Color fundus image.
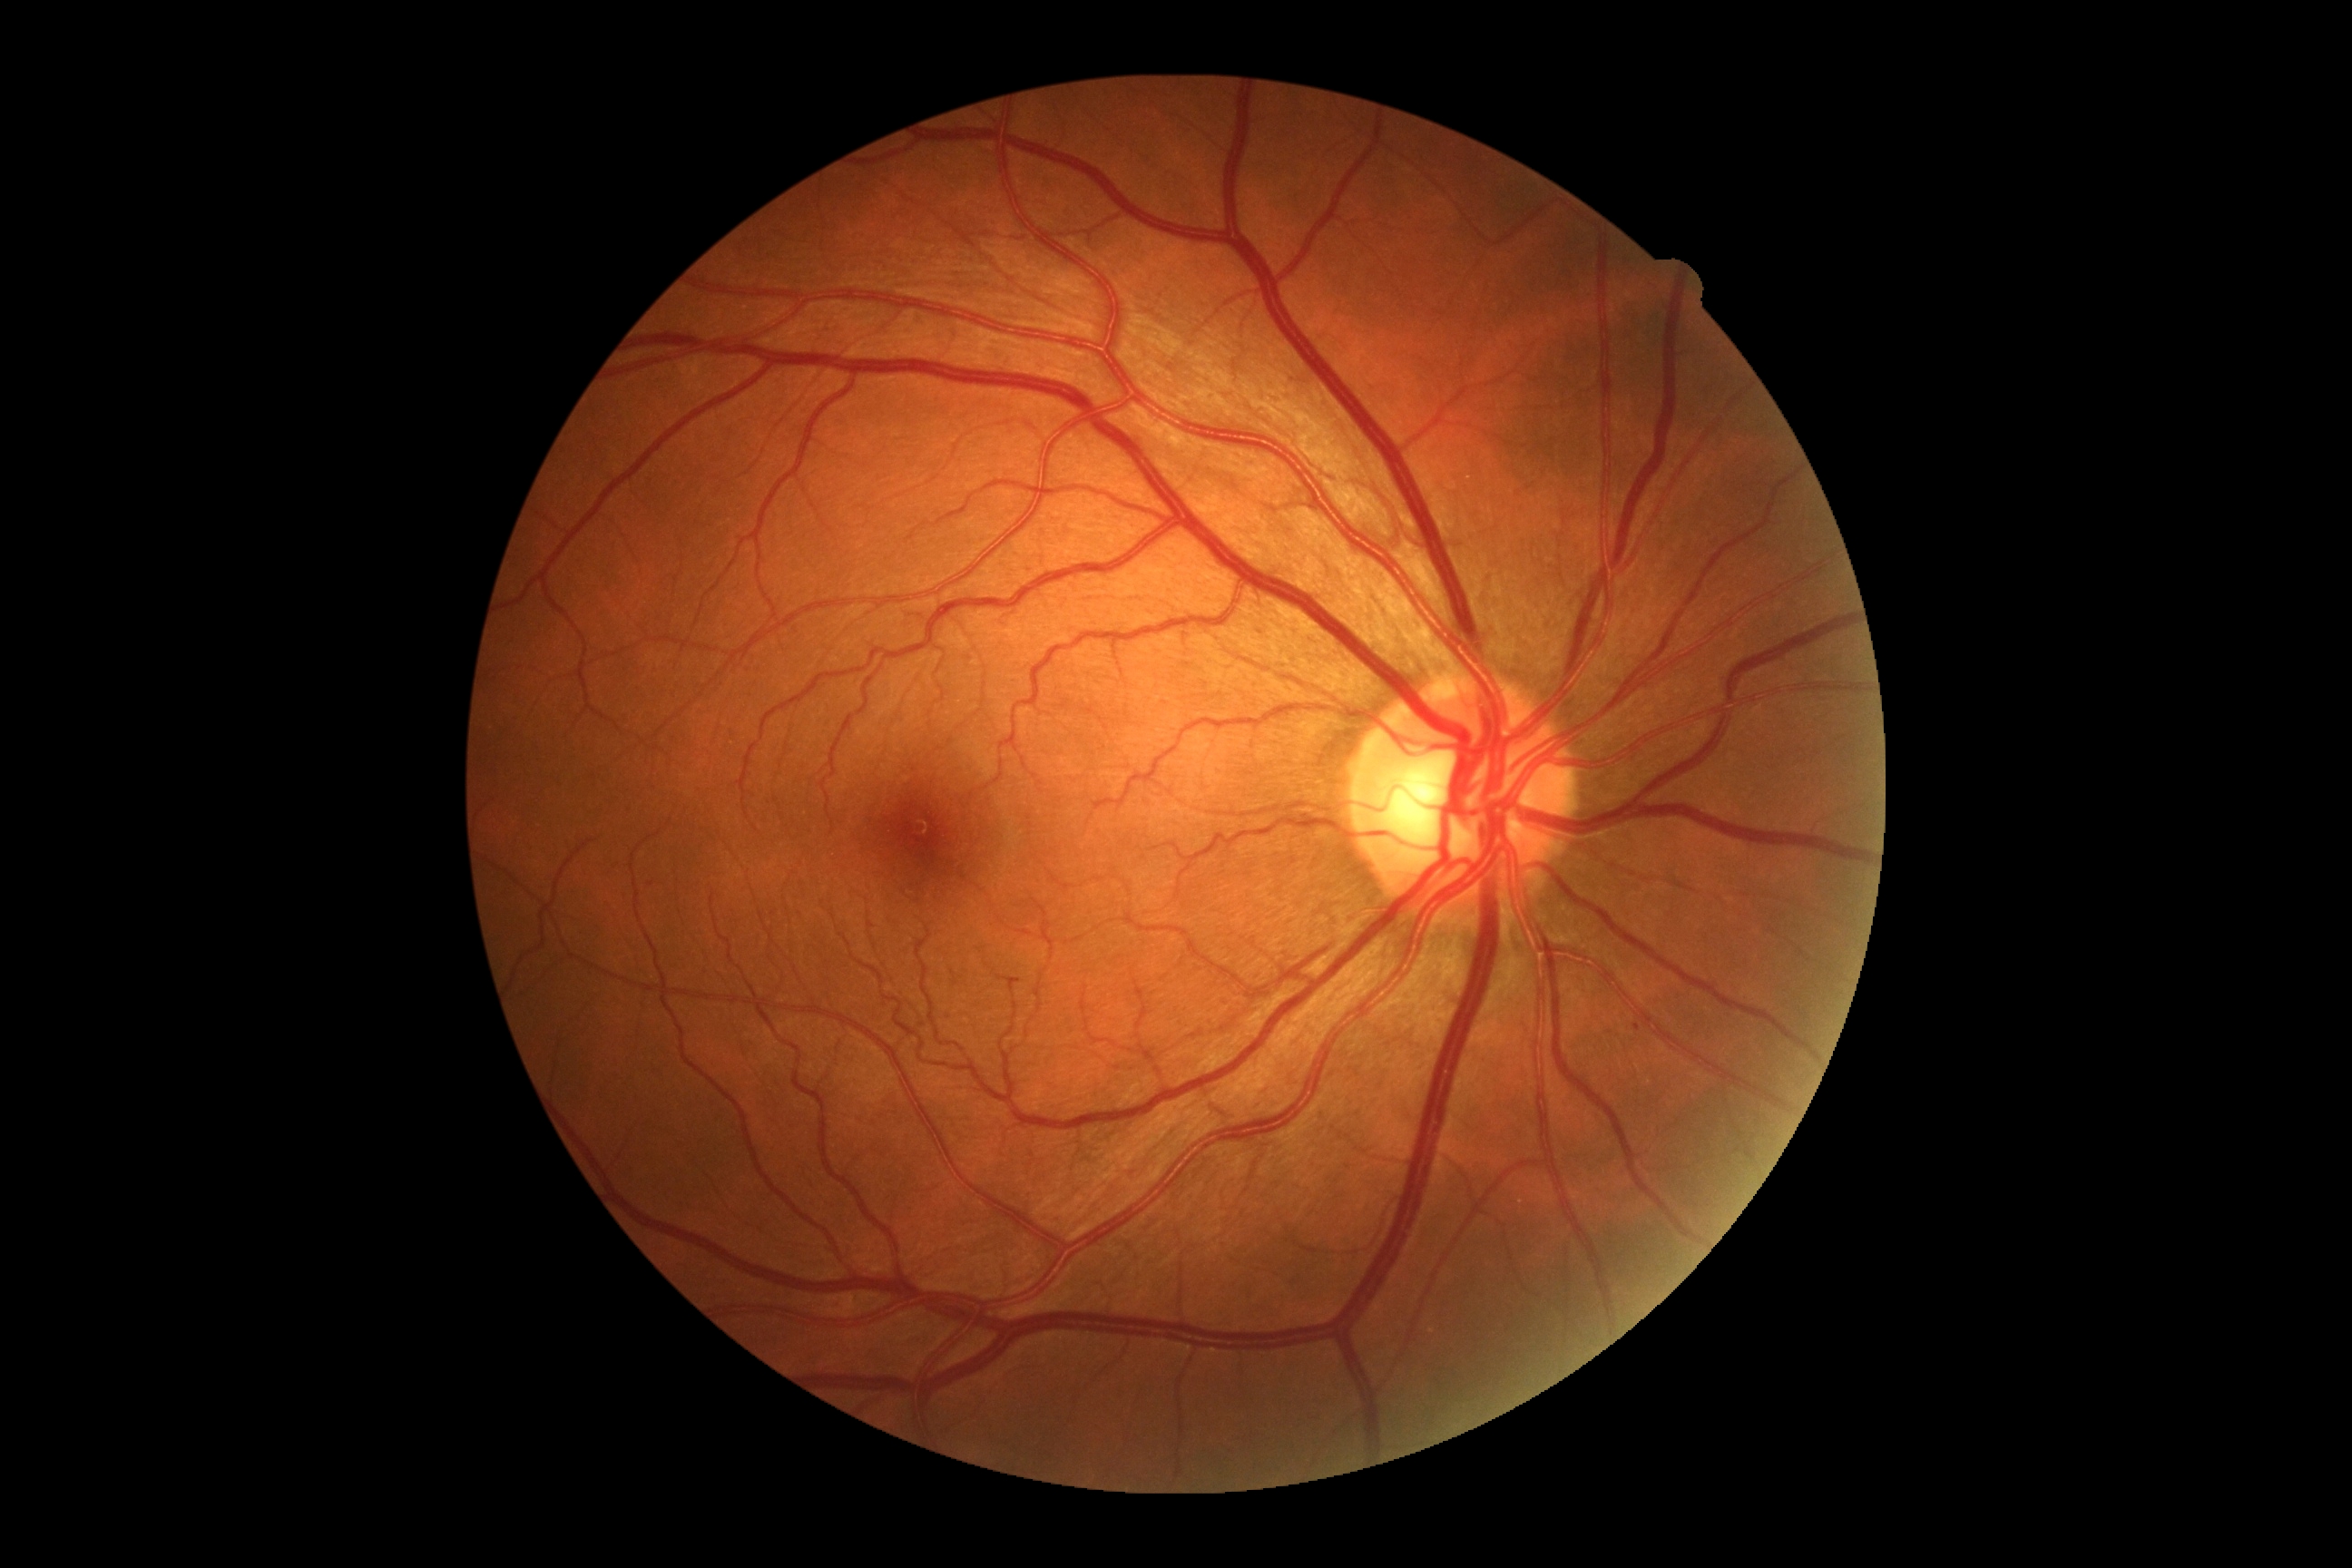 DR stage=no apparent retinopathy (grade 0), DR impression=no apparent DR.